1932 by 1916 pixels — 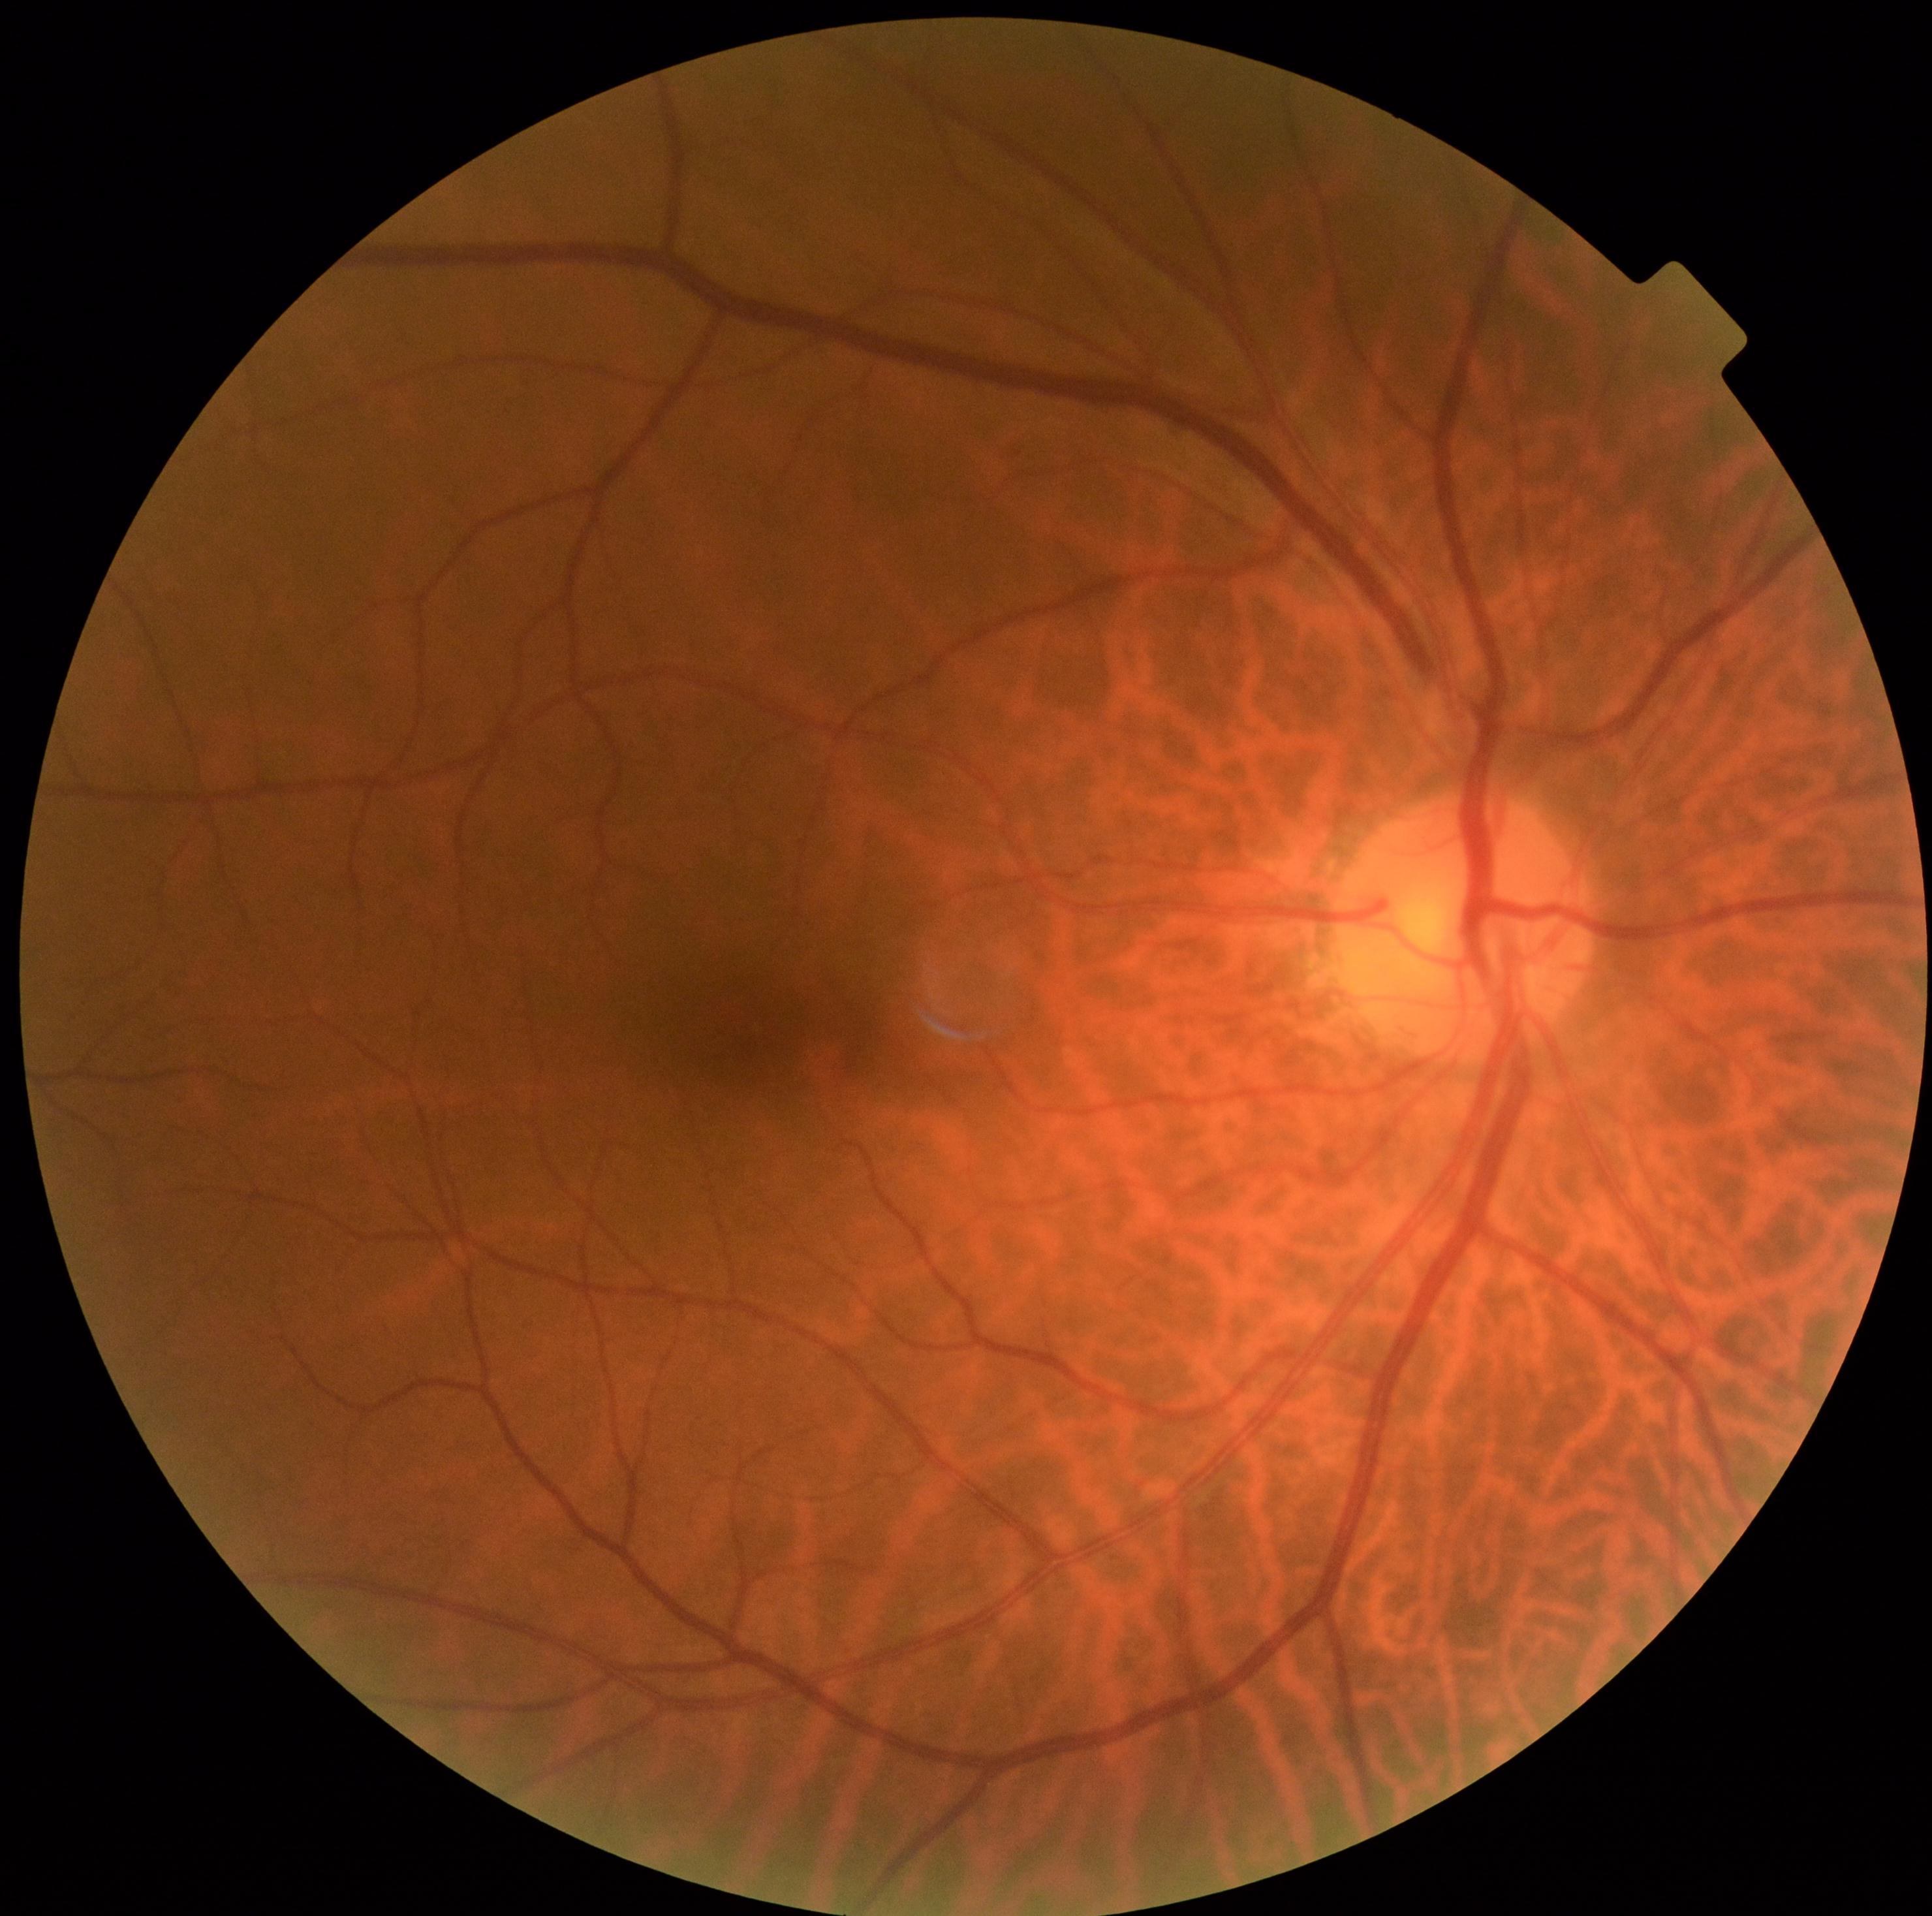

DR grade is 0.